Fundus photo, 512 by 512 pixels: 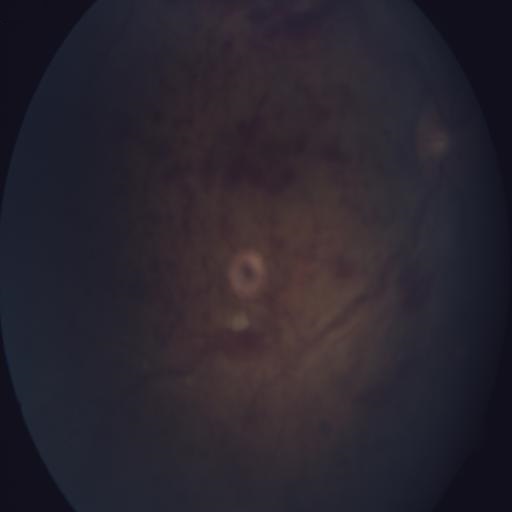
Showing central retinal vein occlusion.